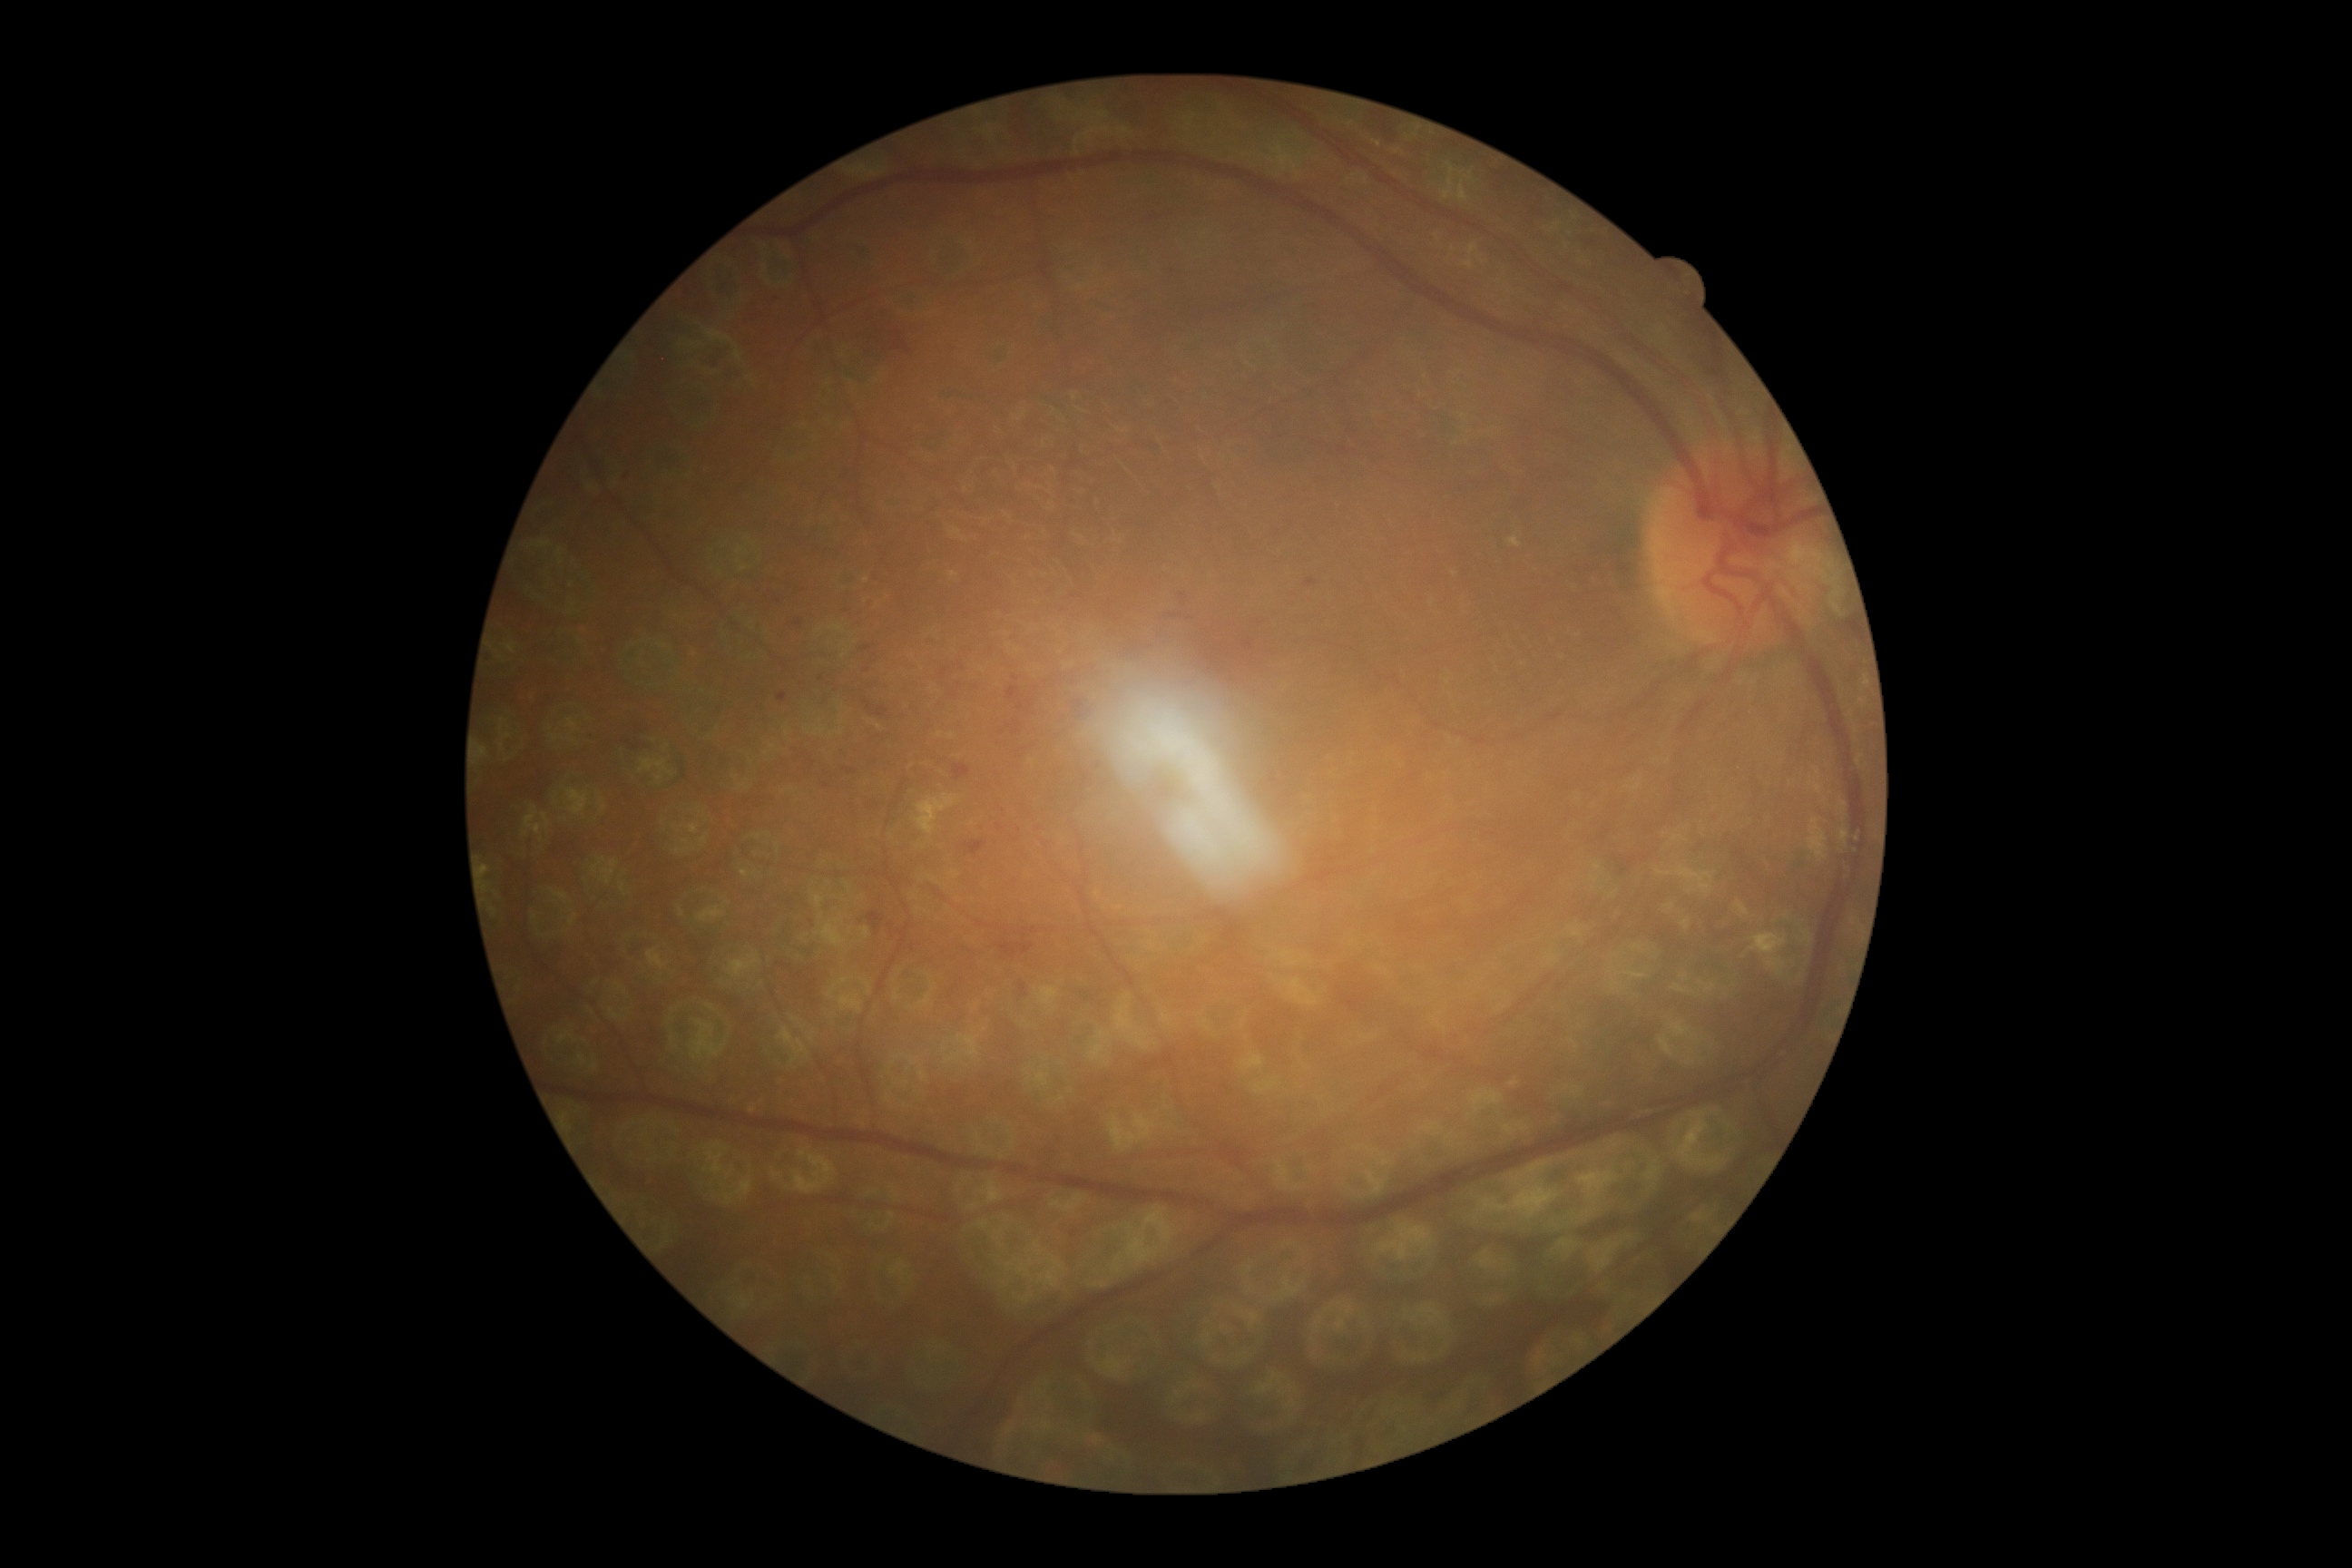

retinopathy grade=2/4.